848x848; 45 degree fundus photograph.
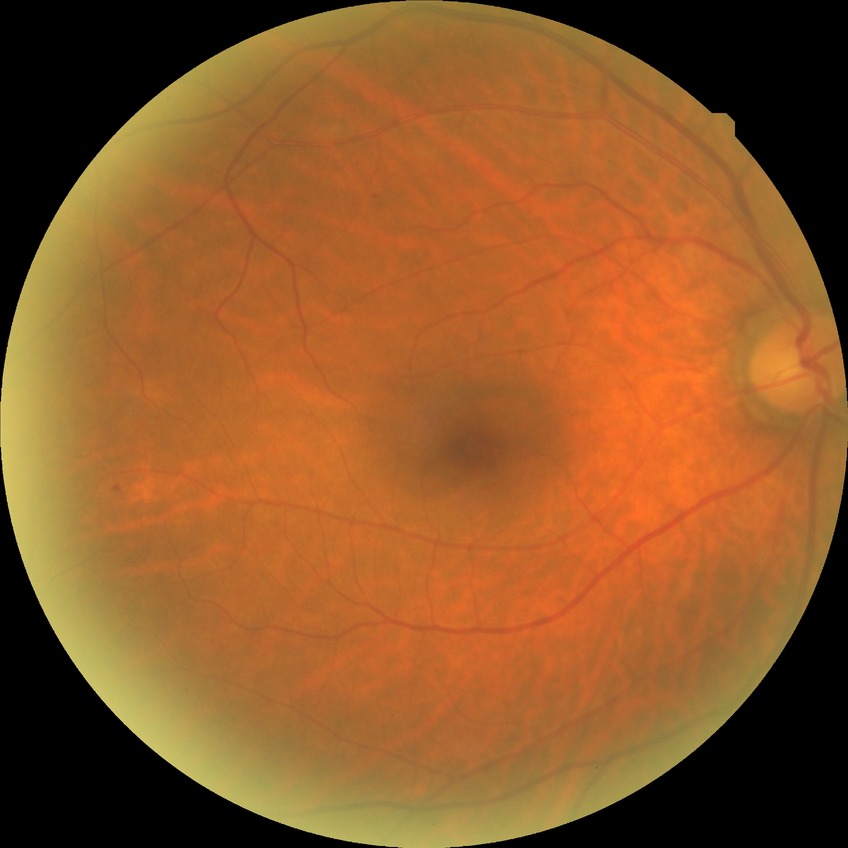 diabetic retinopathy (DR): SDR (simple diabetic retinopathy)